Image size 1960x1897. Fundus photo
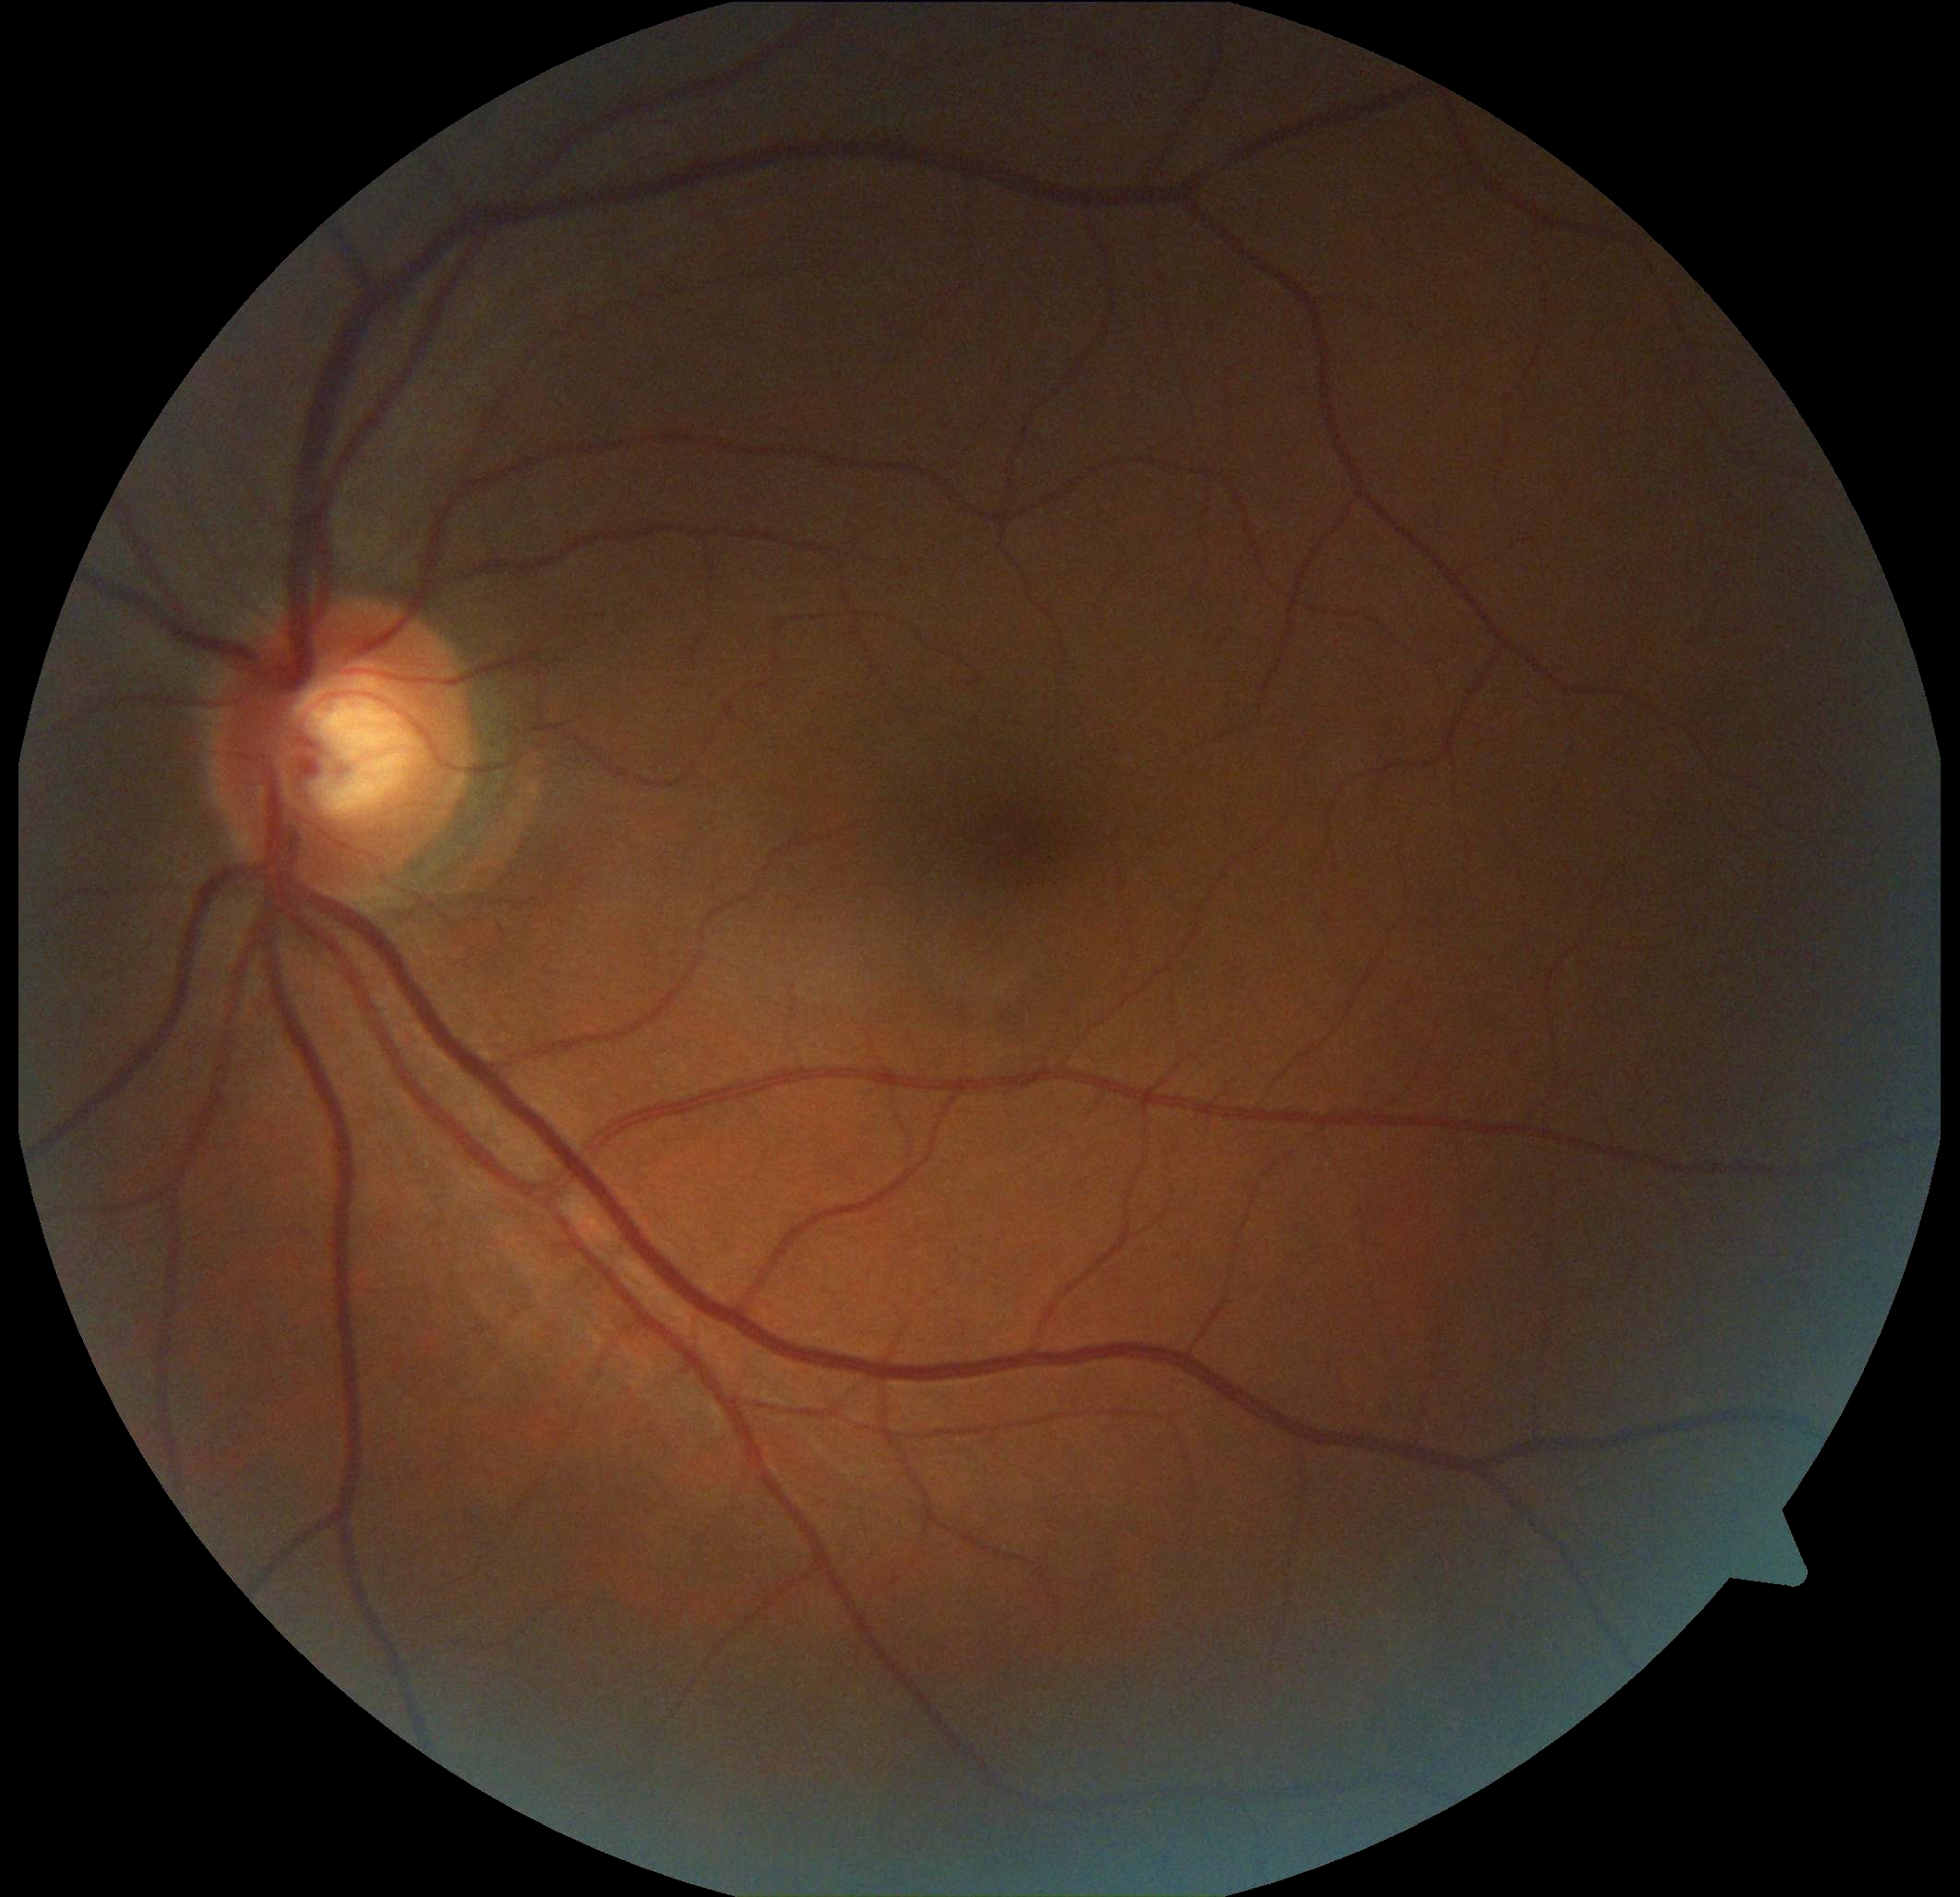
DR is 0/4.